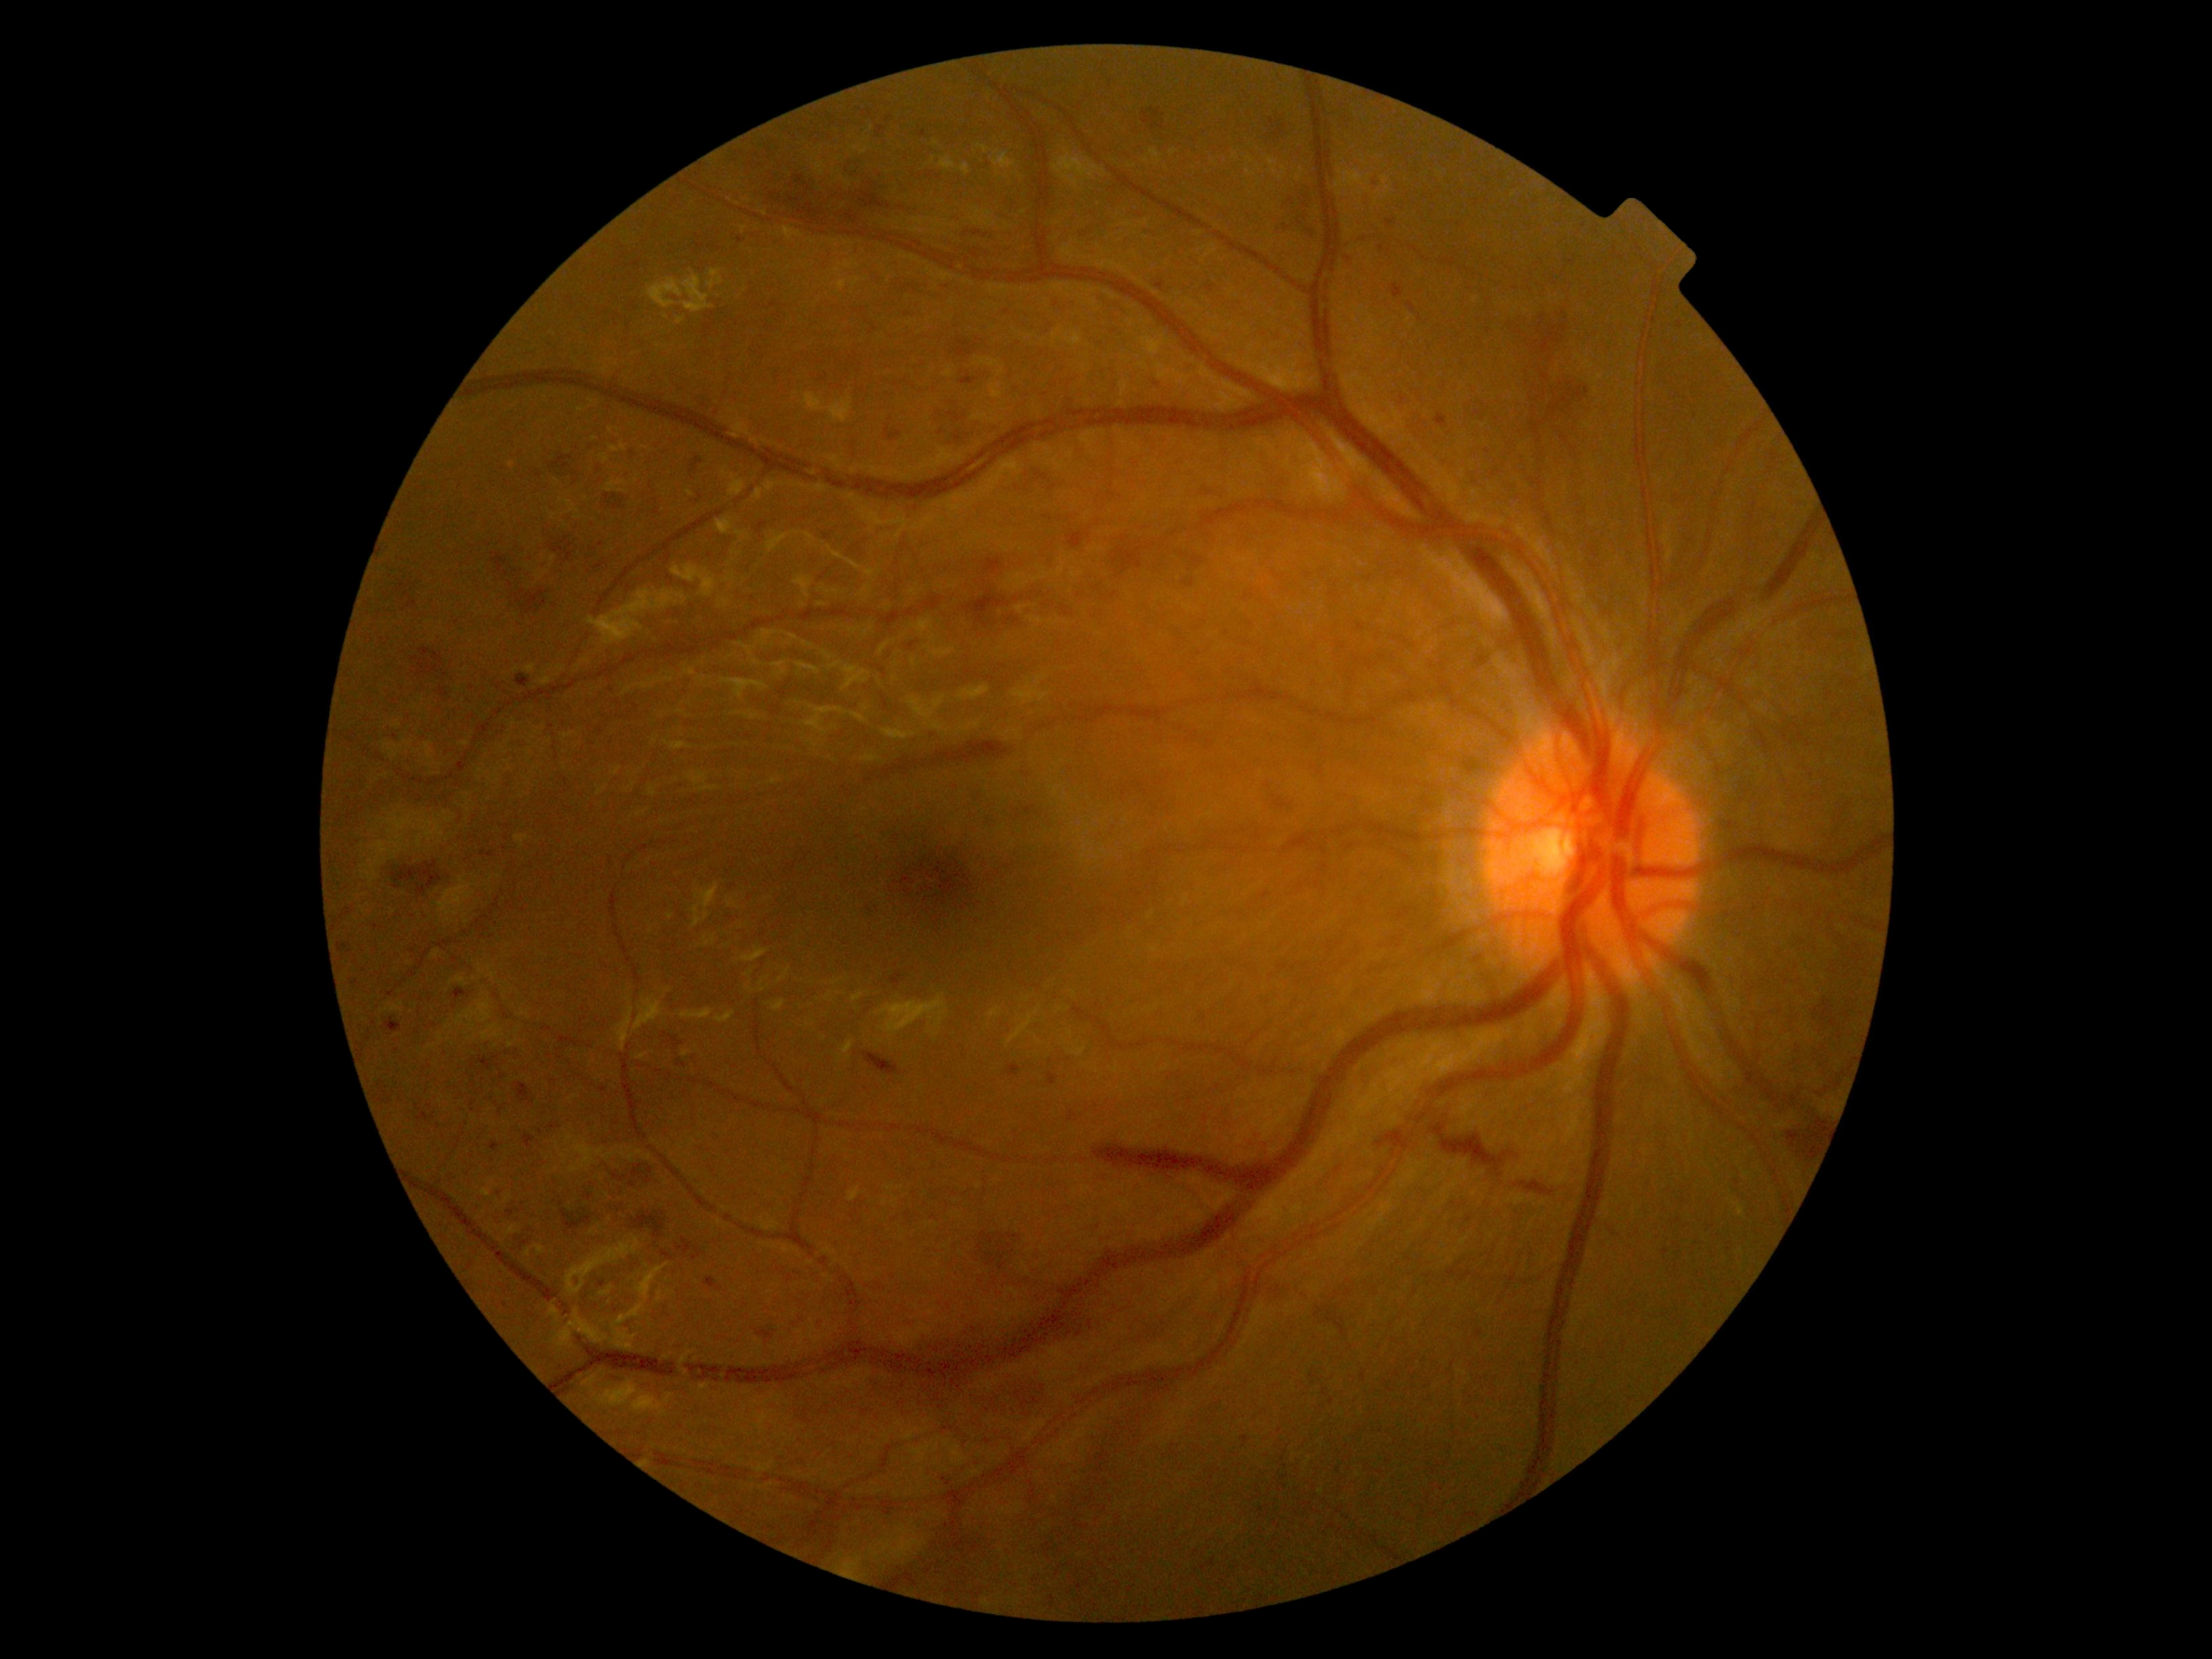 Diabetic retinopathy (DR) is severe non-proliferative diabetic retinopathy (grade 3)
Selected lesions:
hemorrhages (HEs) (subset): (left=546, top=533, right=582, bottom=563) | (left=490, top=1142, right=501, bottom=1150) | (left=1048, top=1074, right=1059, bottom=1086) | (left=933, top=407, right=1005, bottom=453) | (left=693, top=398, right=715, bottom=419) | (left=1024, top=806, right=1036, bottom=815) | (left=548, top=456, right=579, bottom=479) | (left=691, top=456, right=703, bottom=474) | (left=663, top=1032, right=684, bottom=1048) | (left=1008, top=1063, right=1021, bottom=1077) | (left=1080, top=230, right=1093, bottom=242) | (left=550, top=1124, right=559, bottom=1128) | (left=1504, top=310, right=1592, bottom=468)
HEs (small, approximate centers) near 356, 983 | 769, 150 | 501, 1111 | 1737, 1182 | 649, 1180 | 663, 1213